Color fundus image.
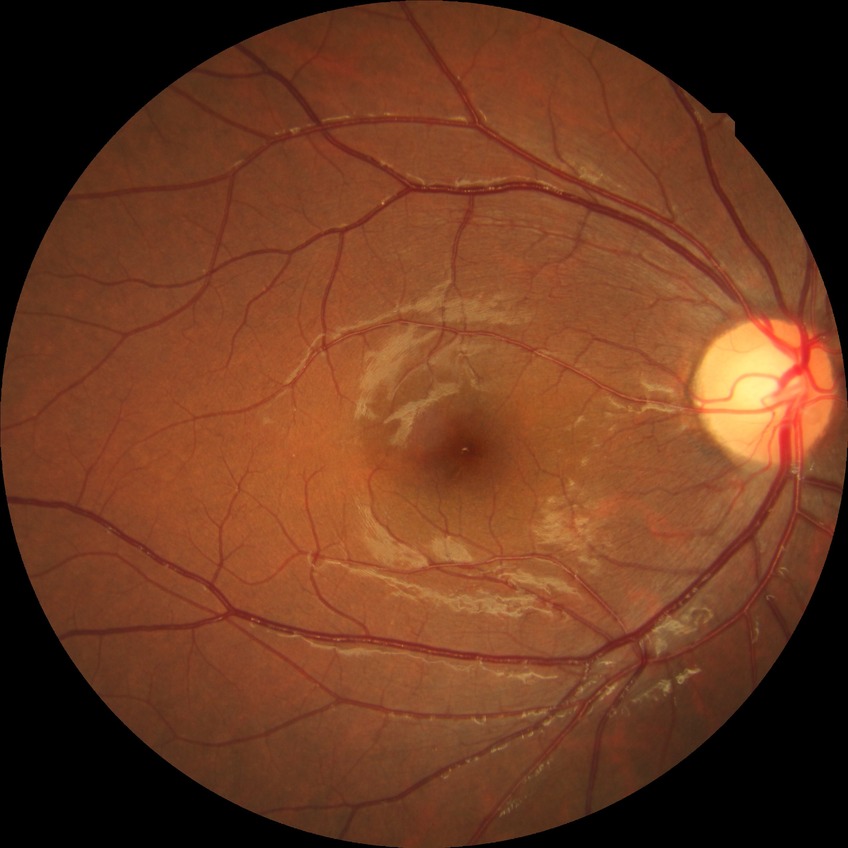

Diabetic retinopathy (DR): NDR (no diabetic retinopathy).